CFP.
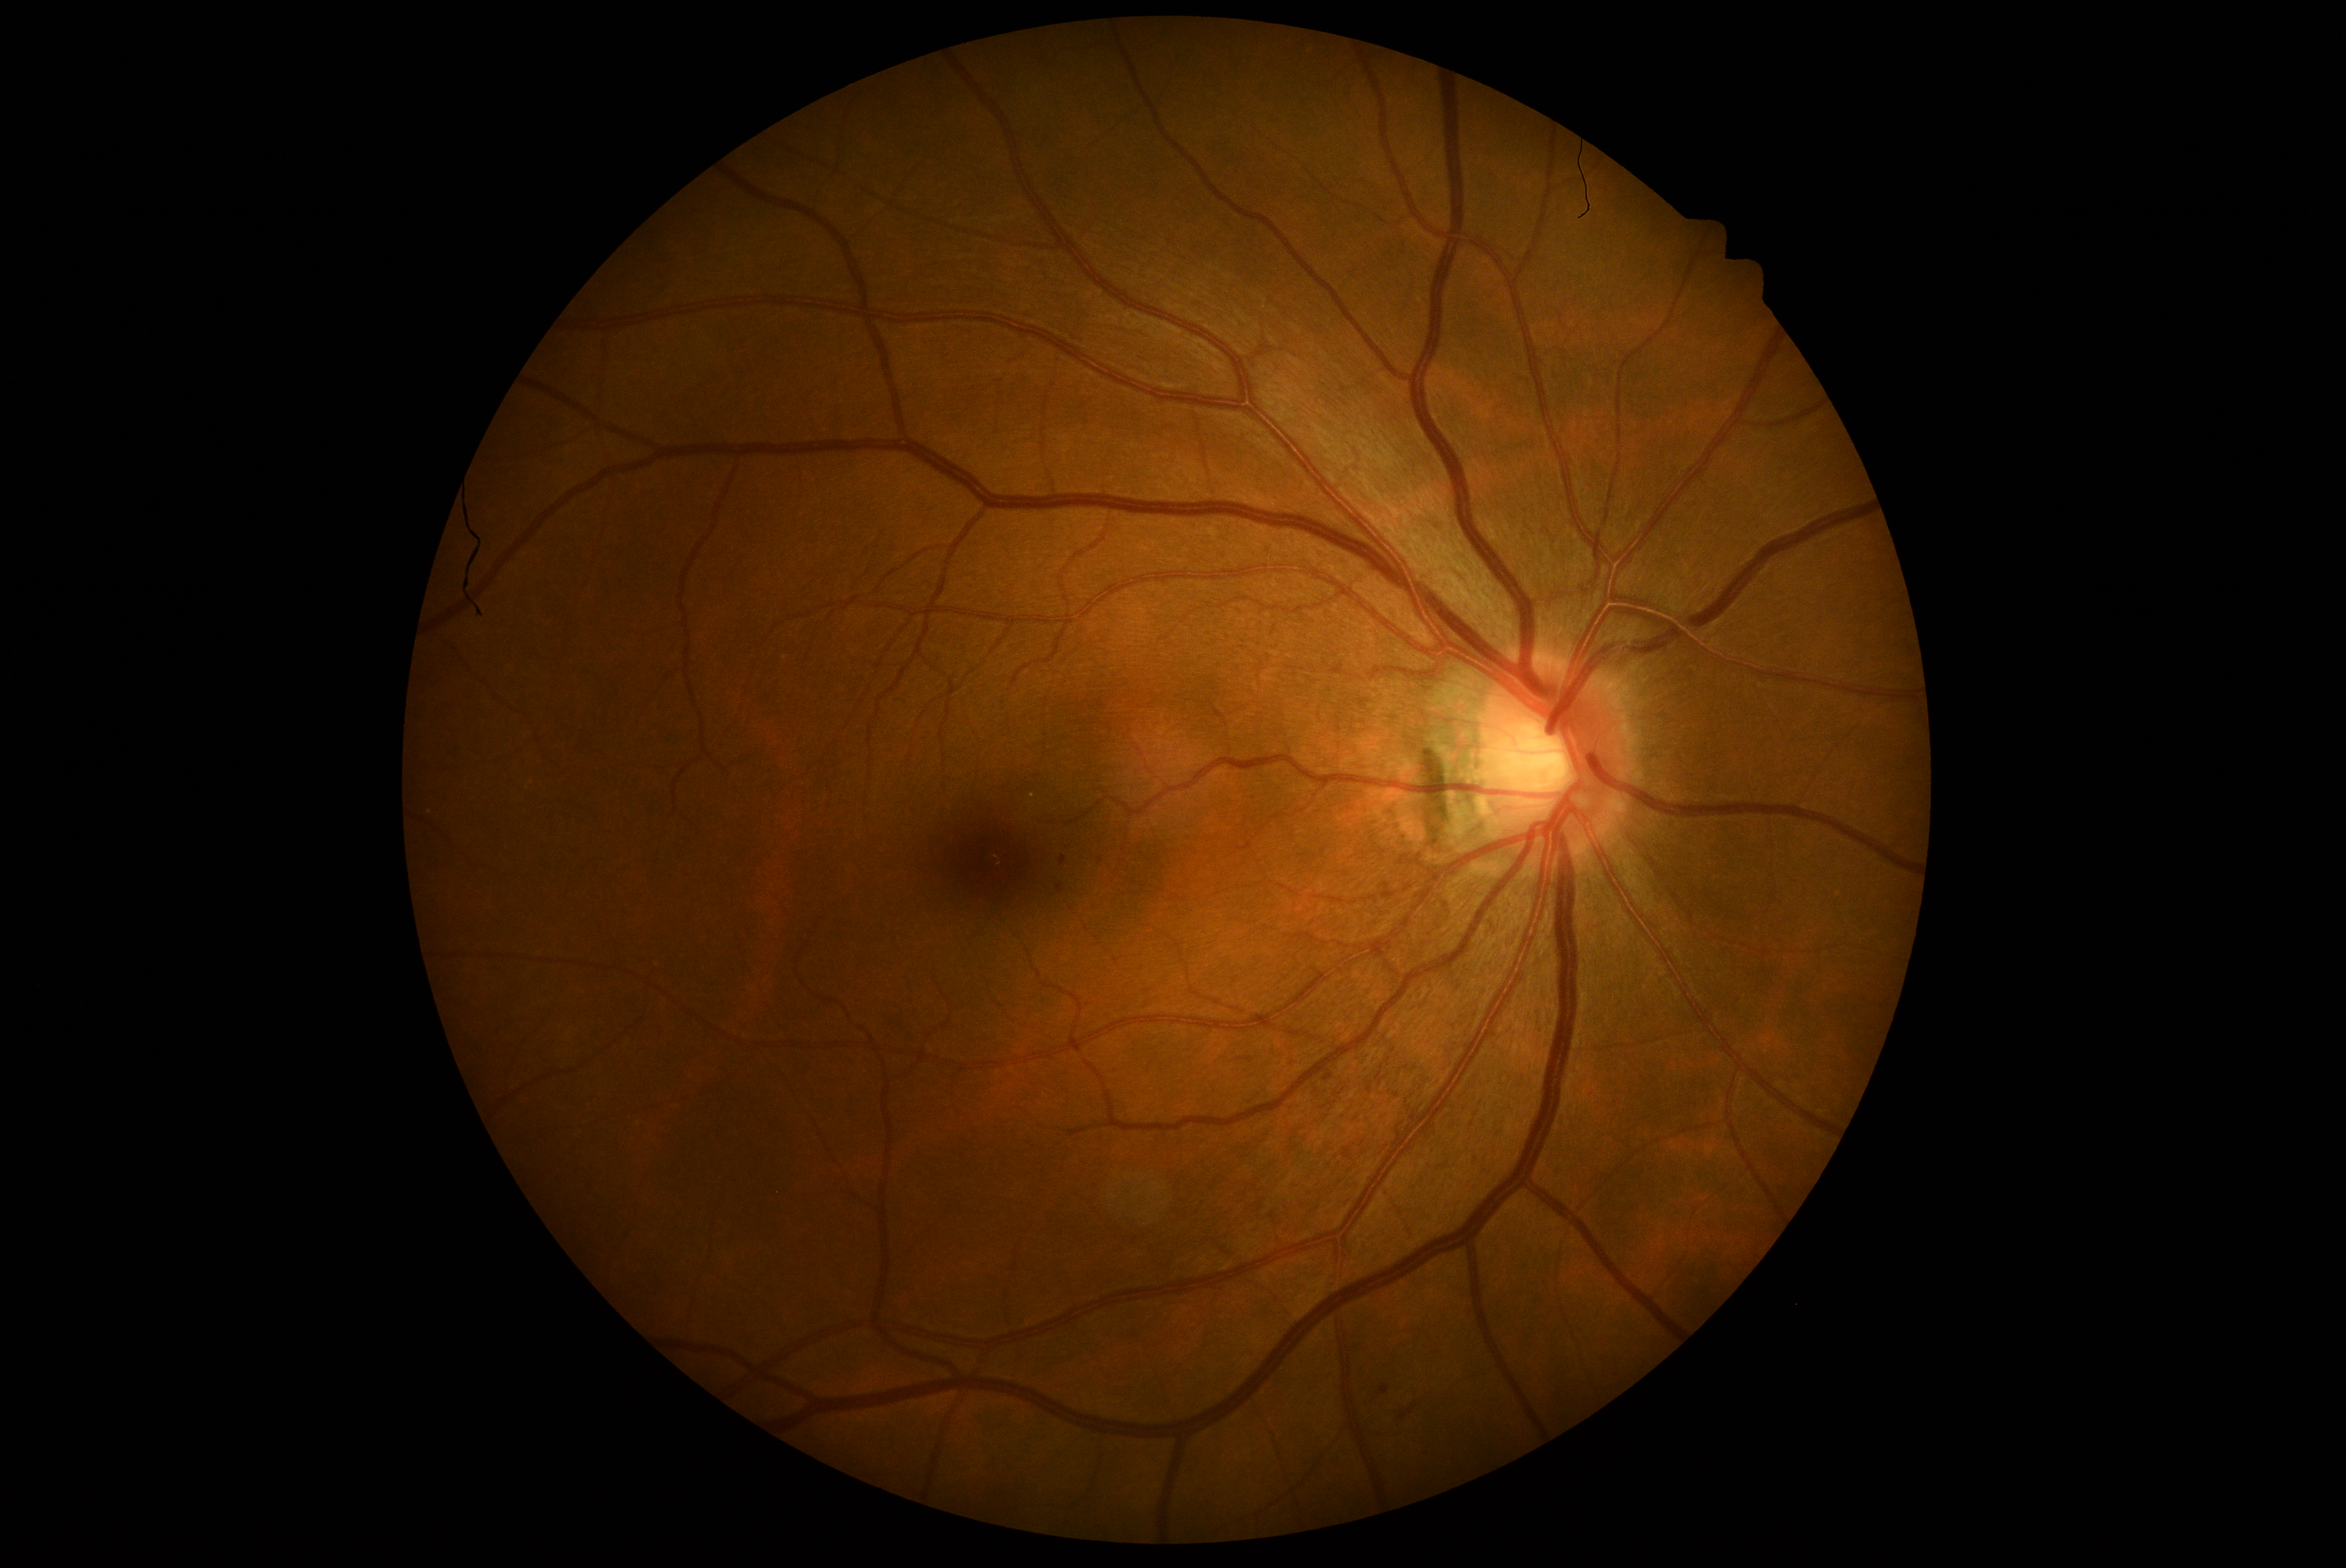 {"dr_grade": "1 — presence of microaneurysms only"}